Handheld portable fundus camera image.
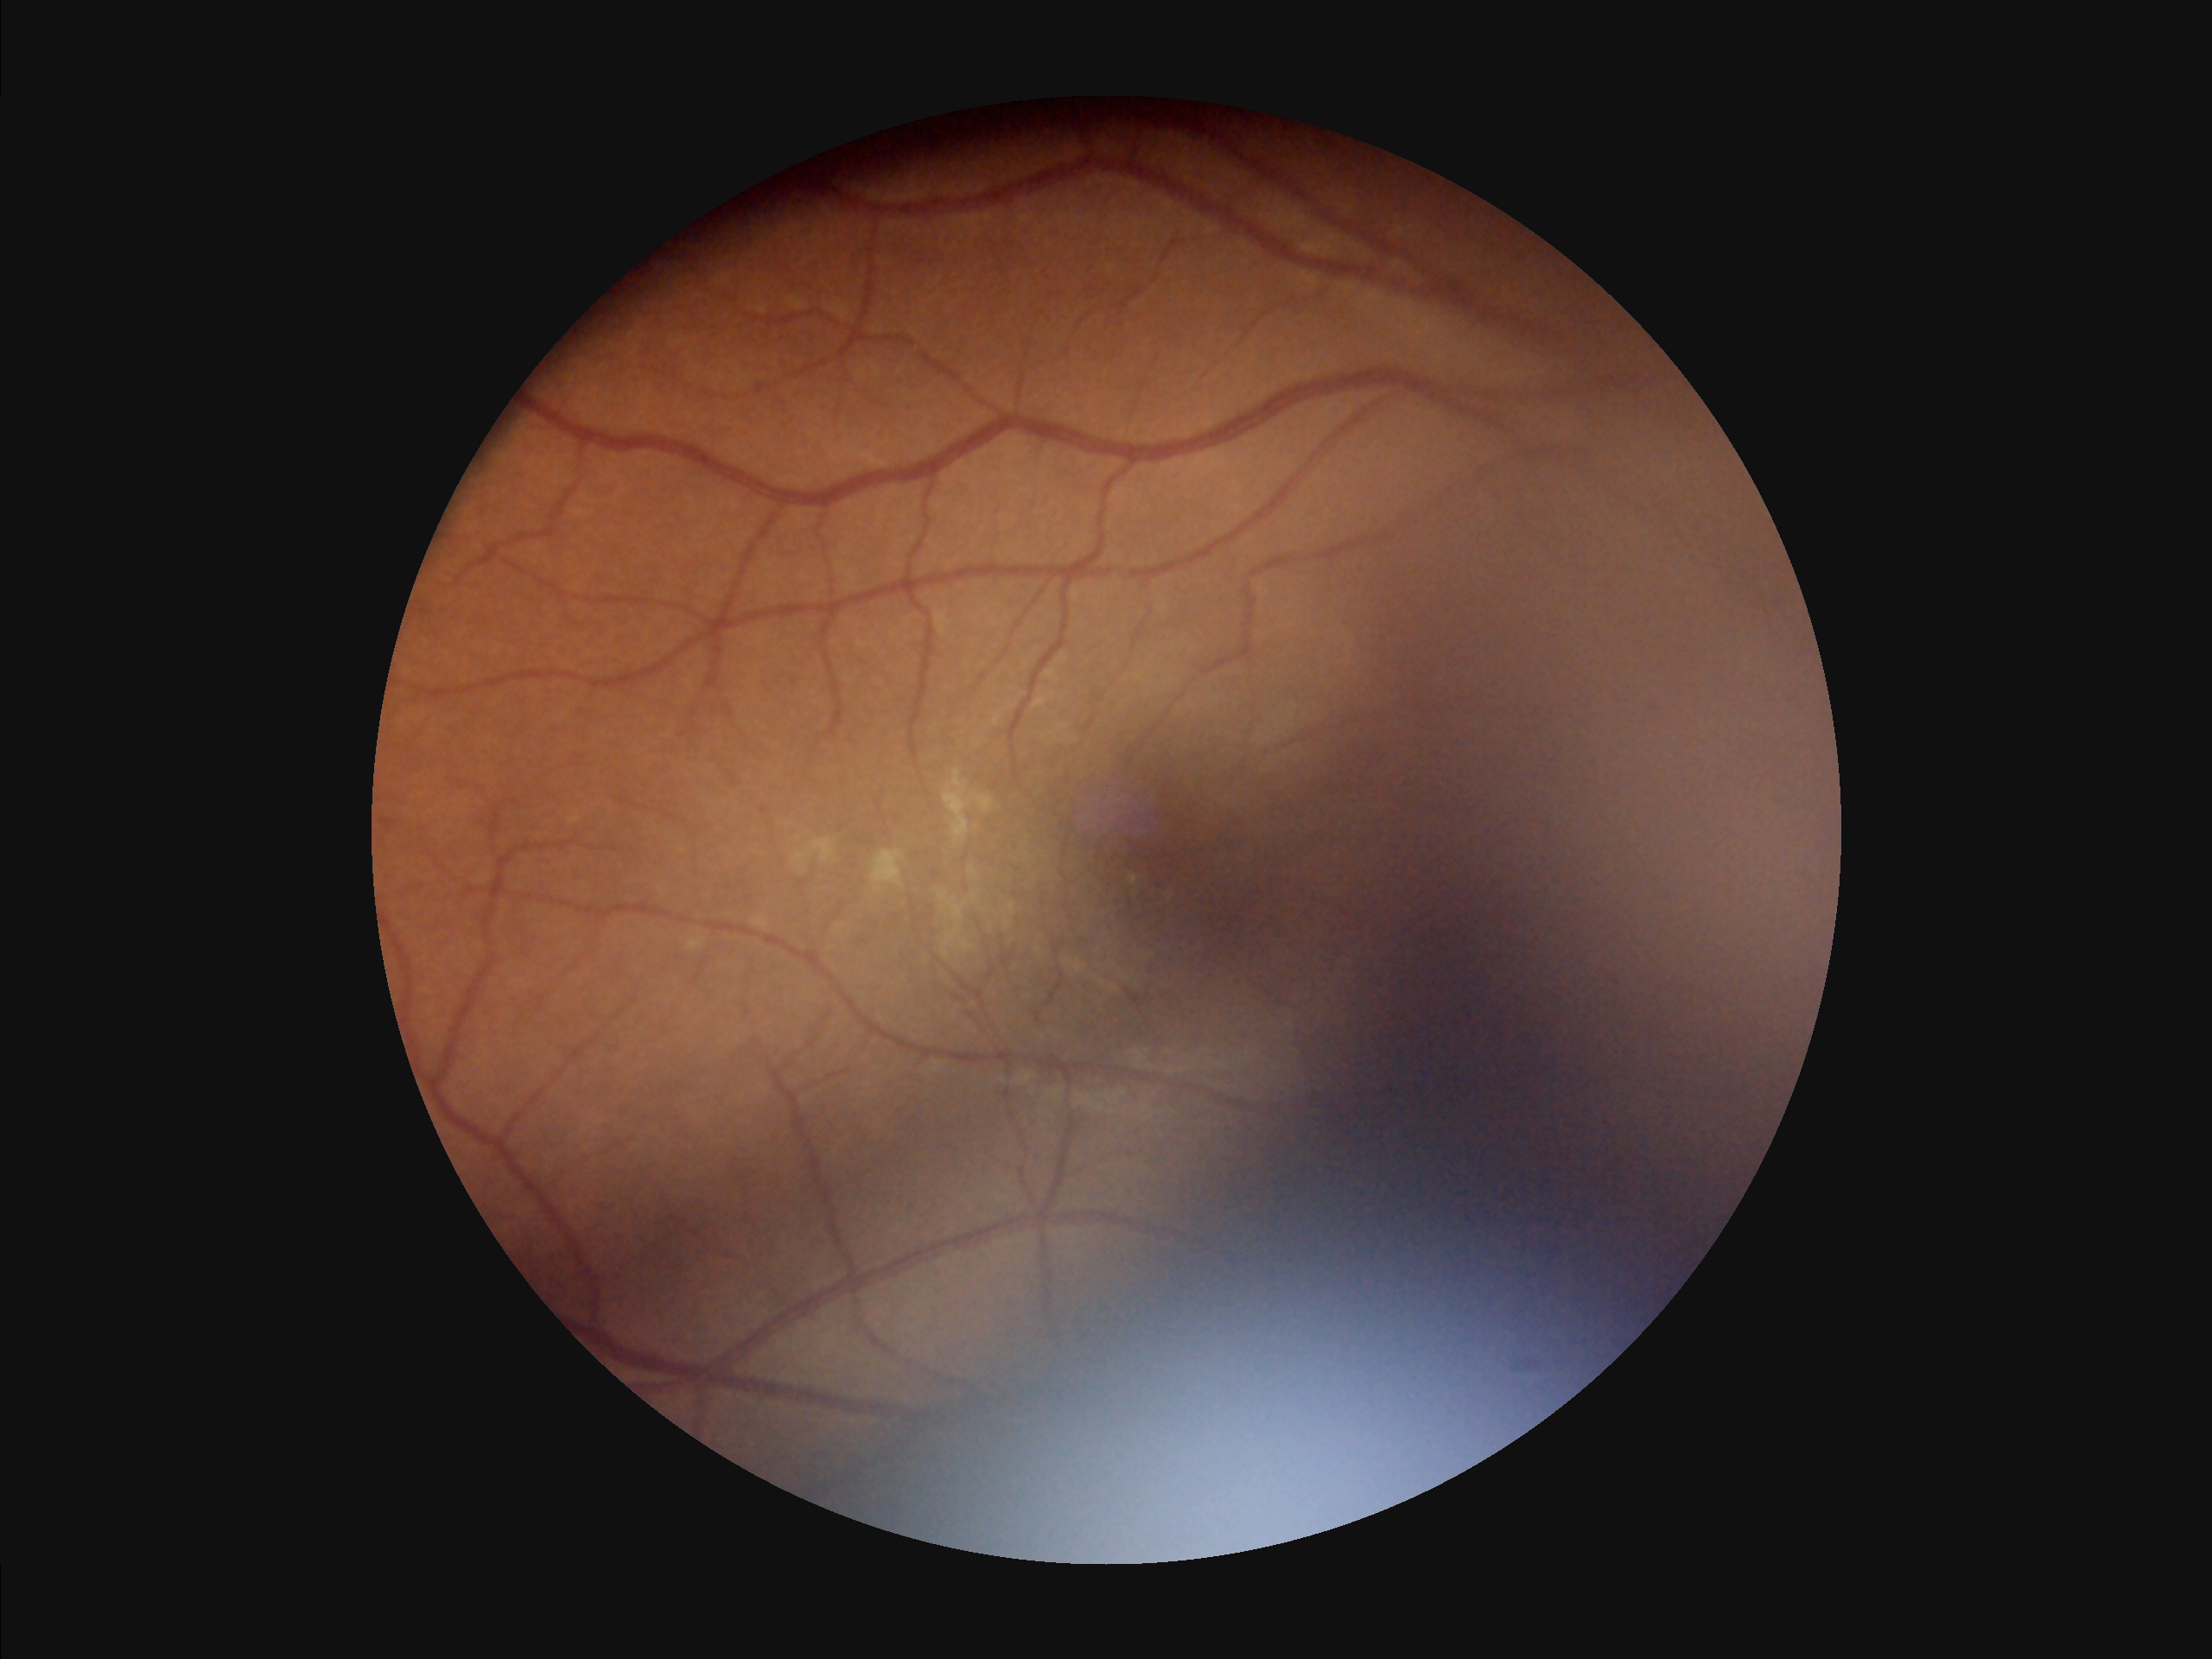 Quality grading: overall: poor and difficult to use diagnostically | illumination: over- or under-exposed | contrast: vessels and details readily distinguishable | focus: out of focus, structures indistinct.